2352 by 1568 pixels. 45° field of view. Color fundus photograph — 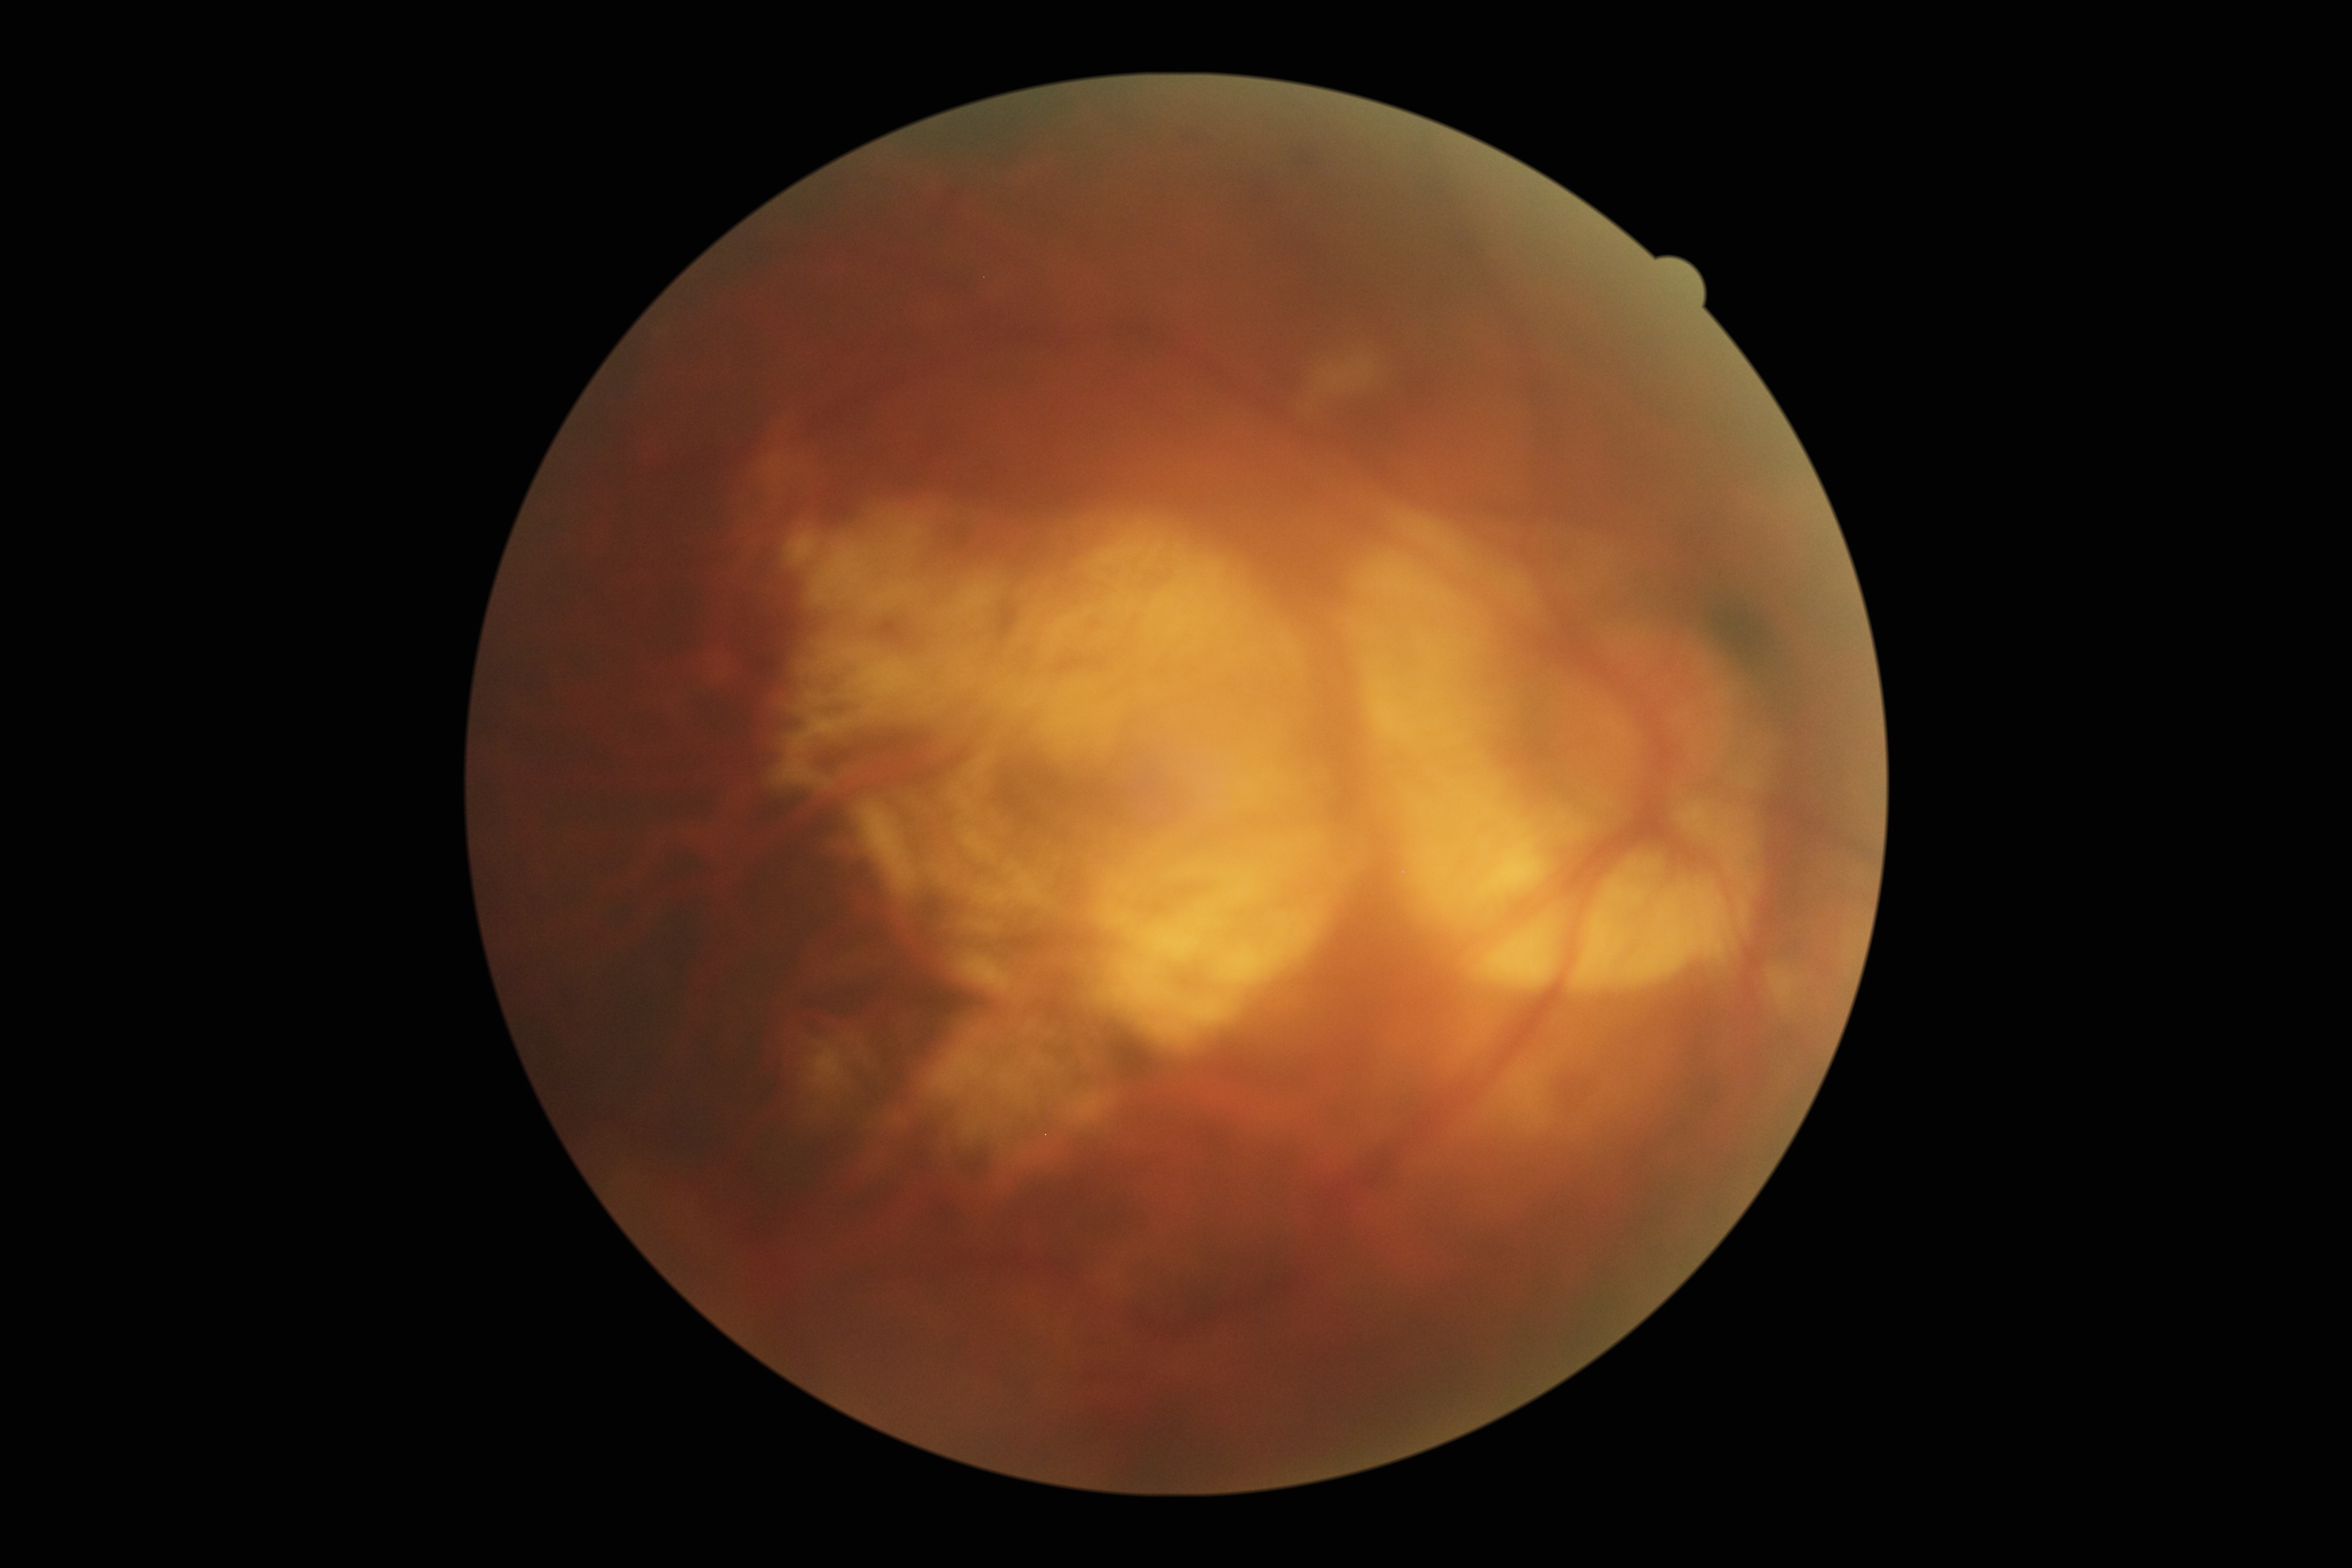
DR is 2.